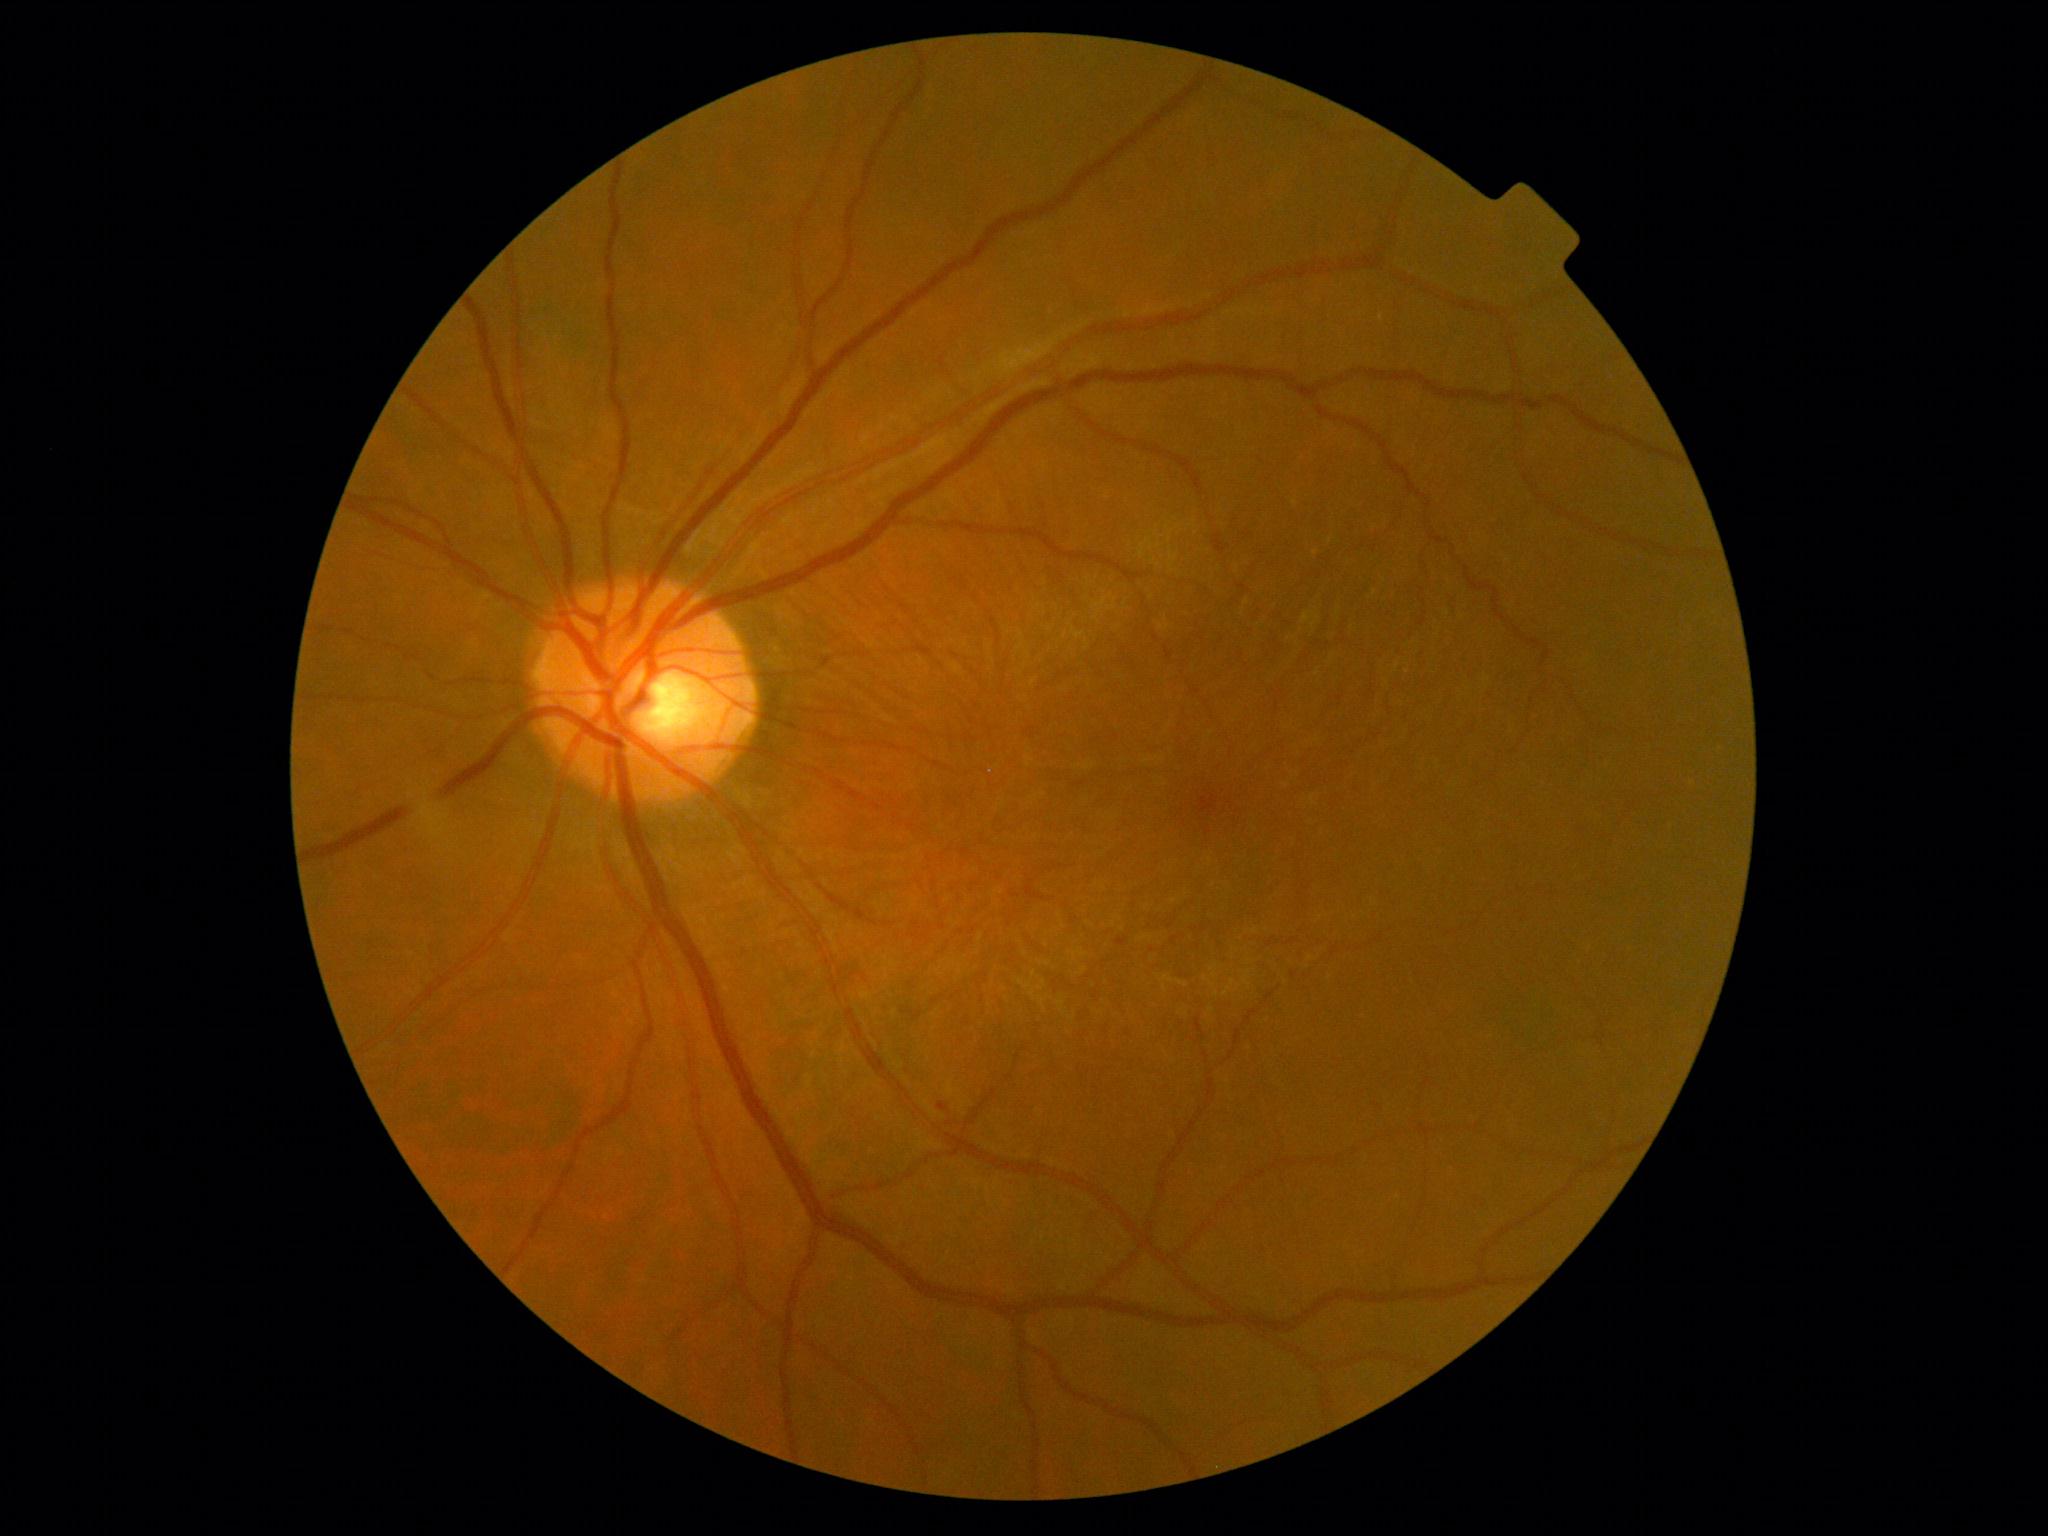 diabetic retinopathy severity: mild non-proliferative diabetic retinopathy (grade 1).